CFP; Remidio Fundus on Phone (FOP) camera.
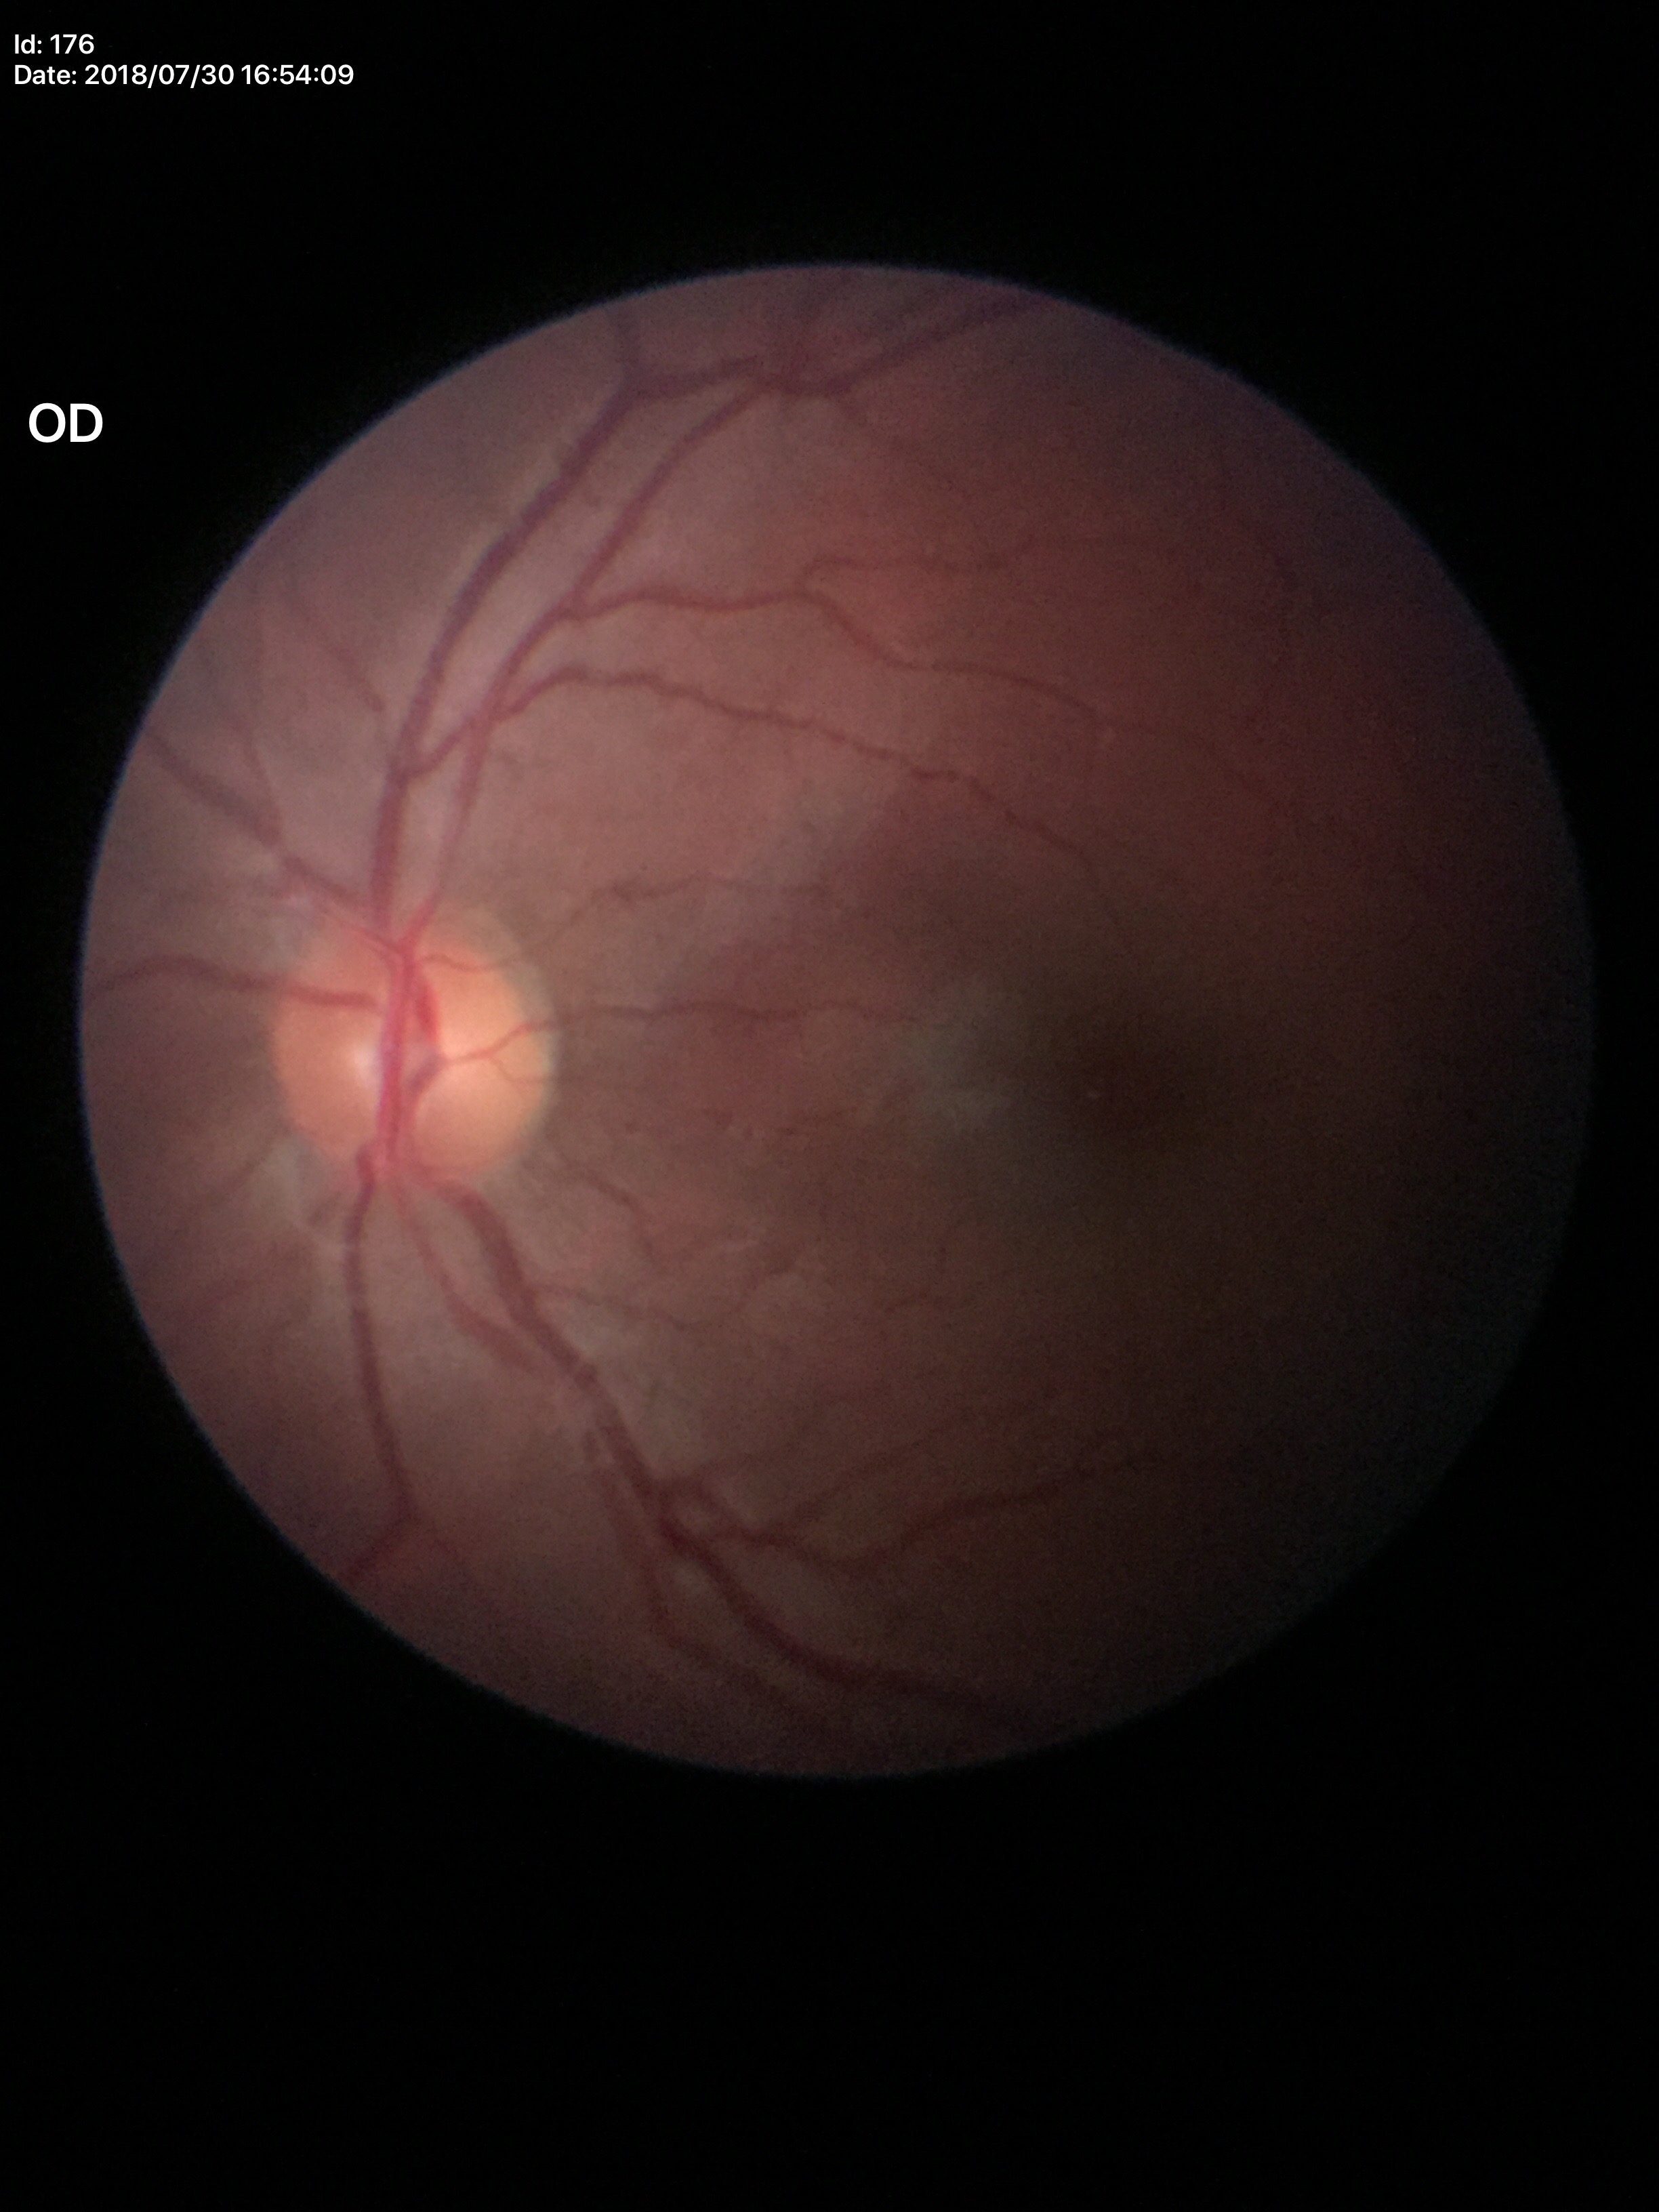

No signs of glaucoma.
Vertical cup-disc ratio (VCDR) is 0.47.
Horizontal cup-disc ratio (HCDR) is 0.46.
Area cup-disc ratio (ACDR) of 0.21.